Fundus photo: 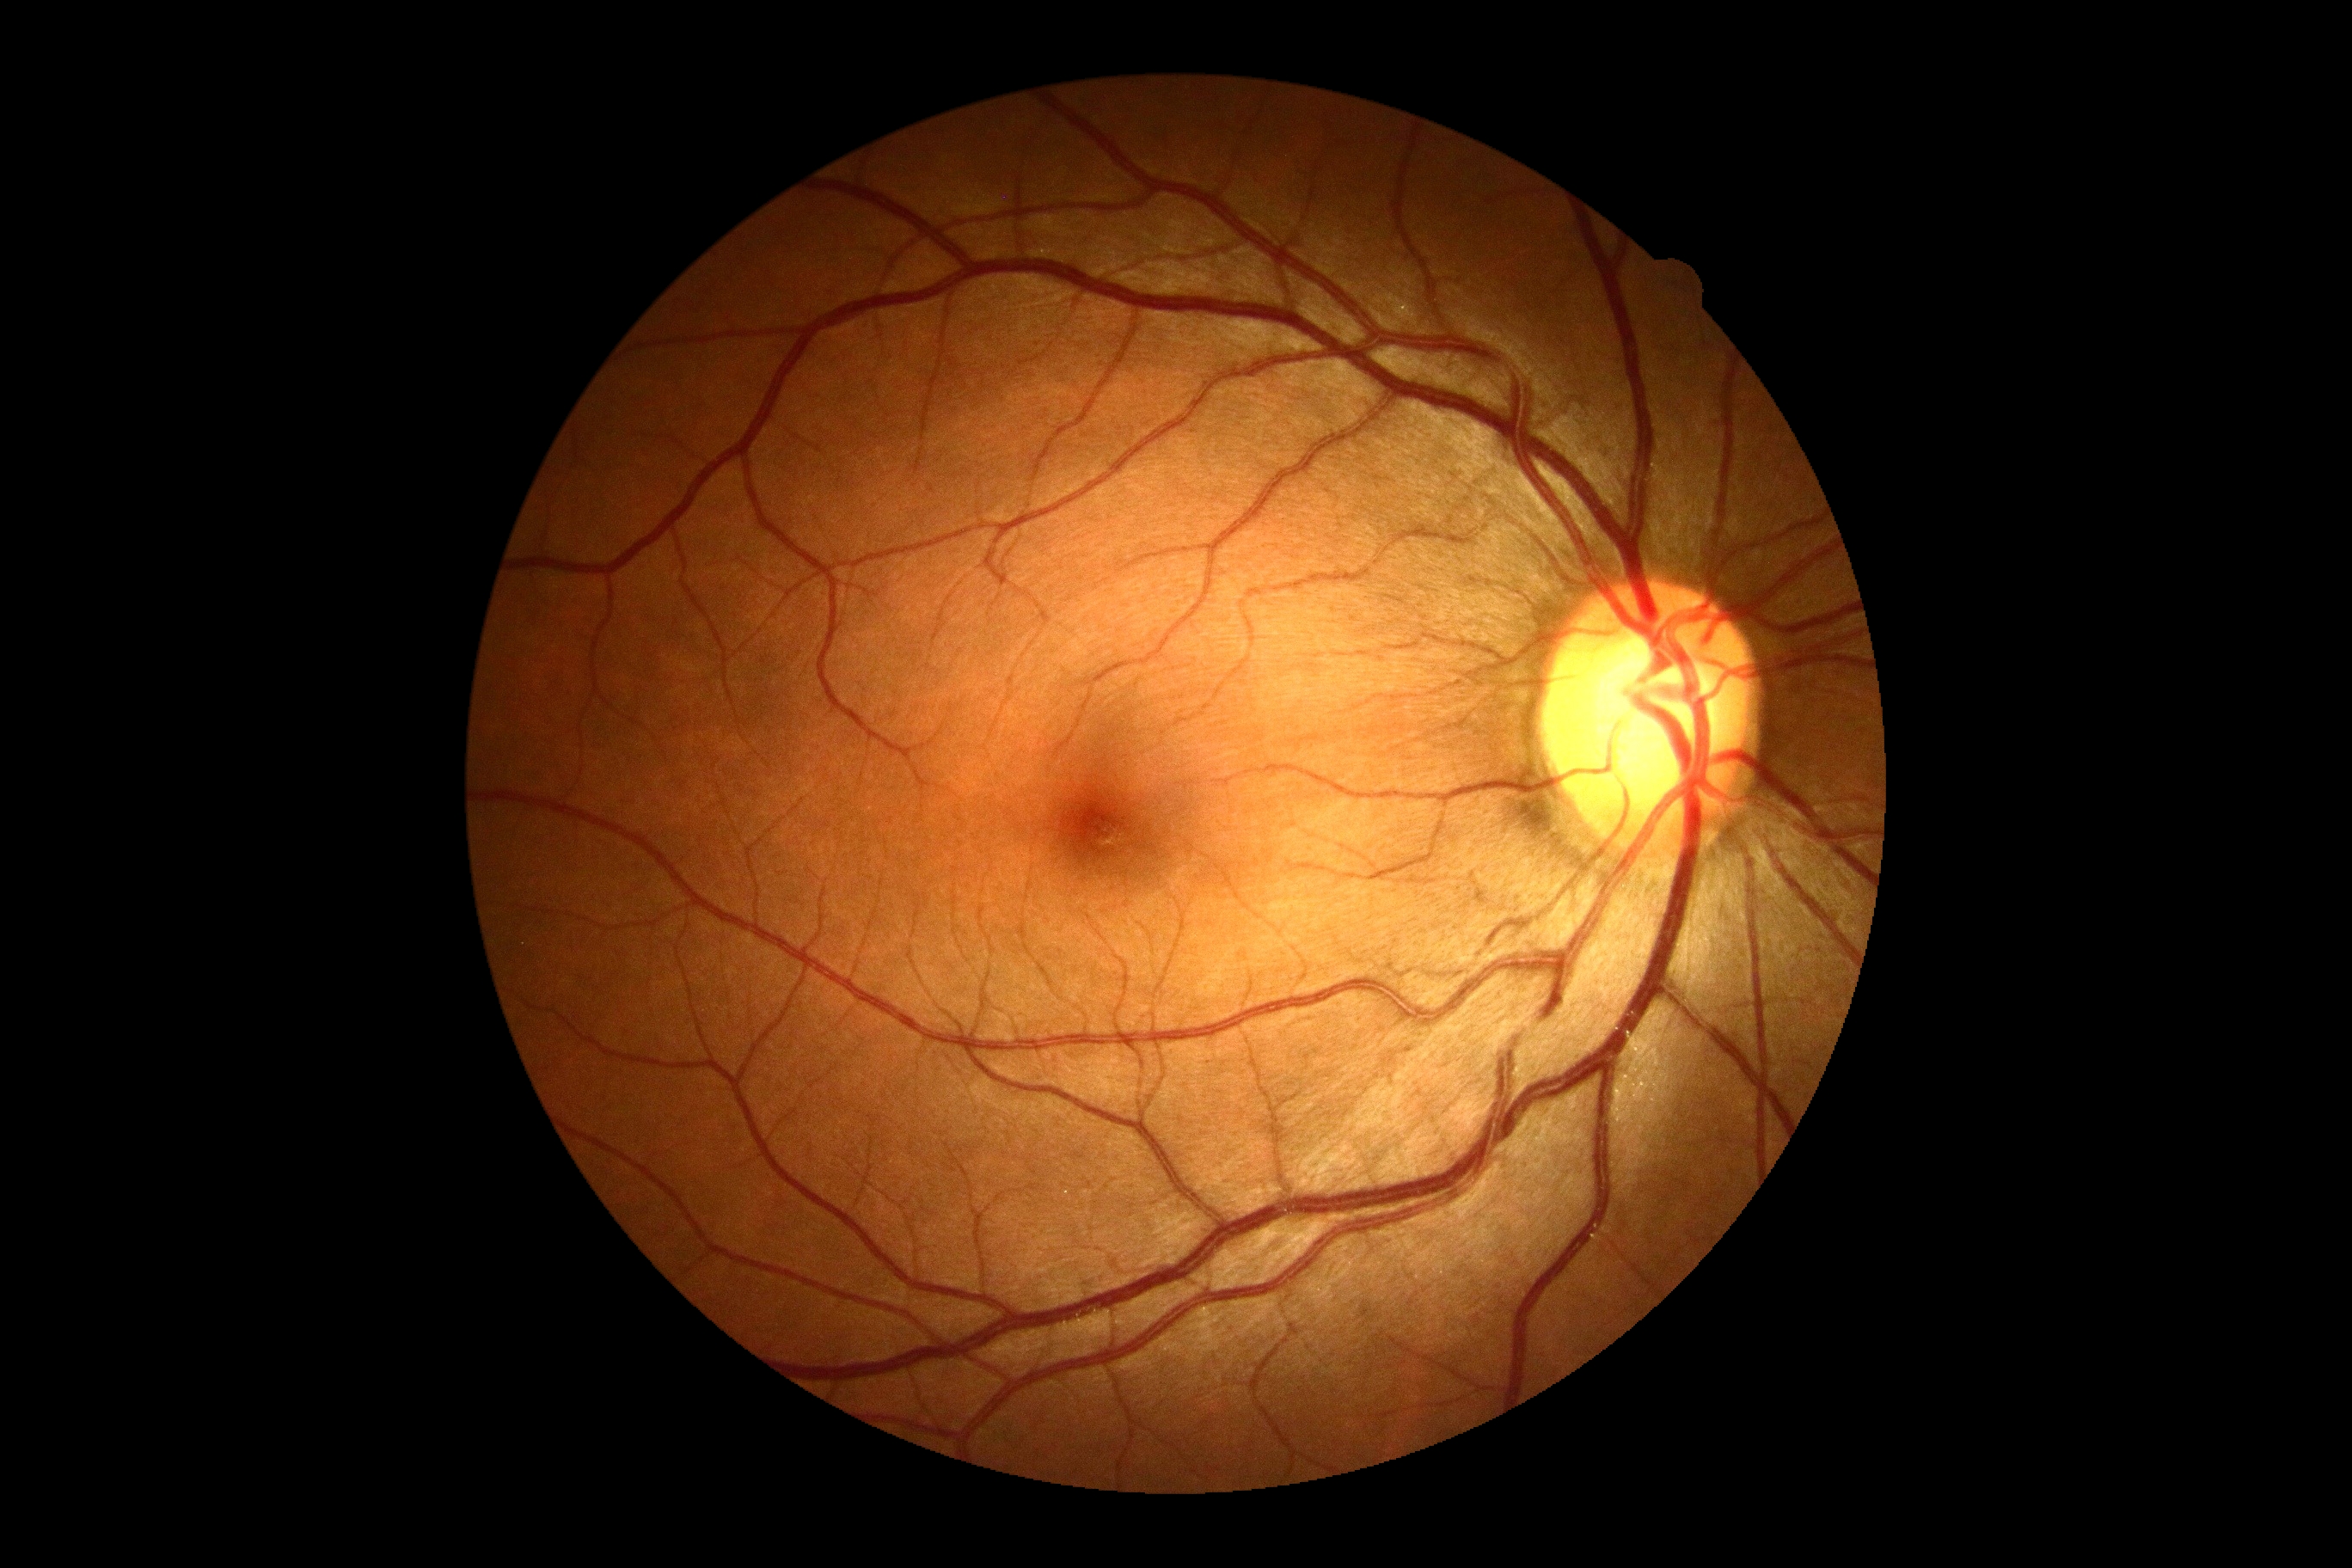
Diabetic retinopathy (DR): no apparent retinopathy (grade 0).